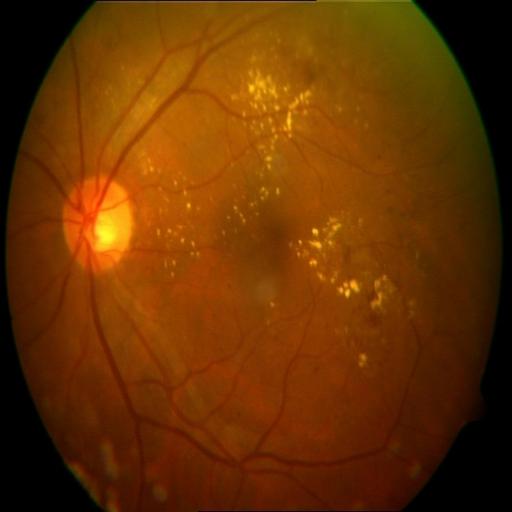
Diagnoses: exudation.